Phoenix ICON wide-field infant fundus image — 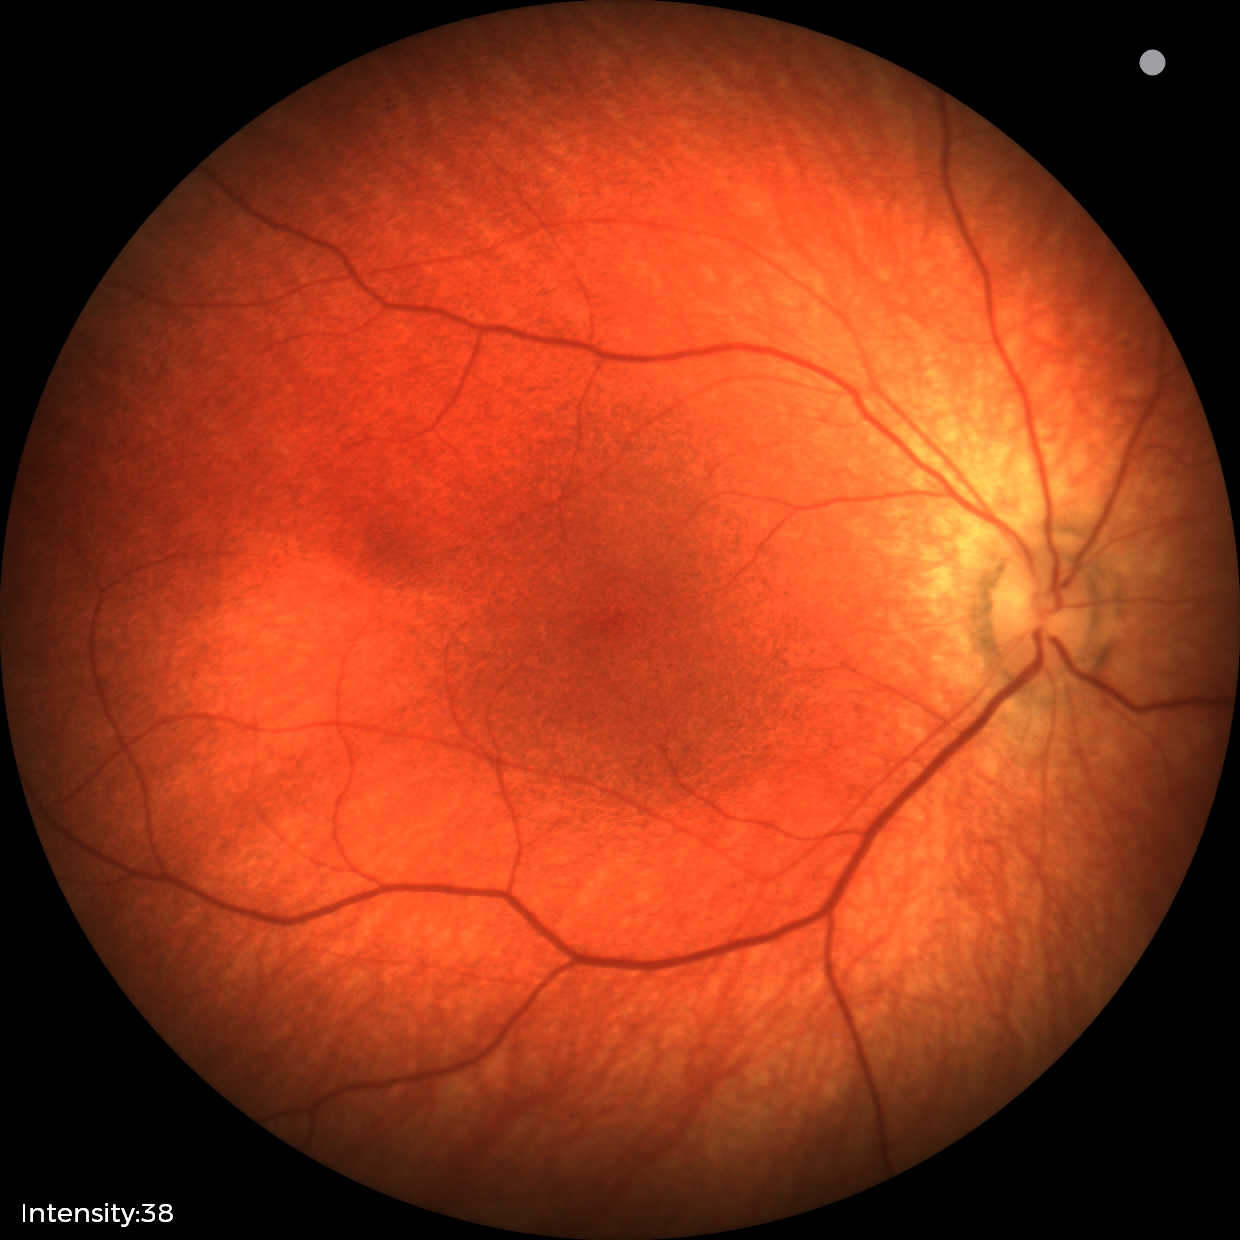

No retinal pathology identified on screening.